Camera: NIDEK AFC-230, 45° field of view, CFP
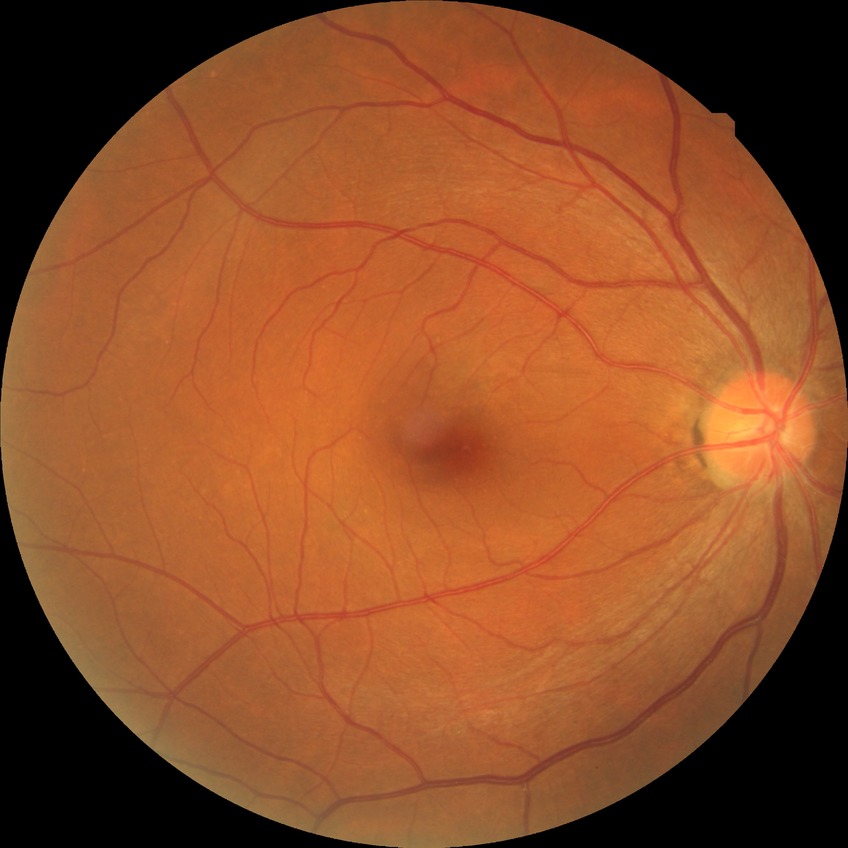
diabetic retinopathy (DR): no diabetic retinopathy (NDR).